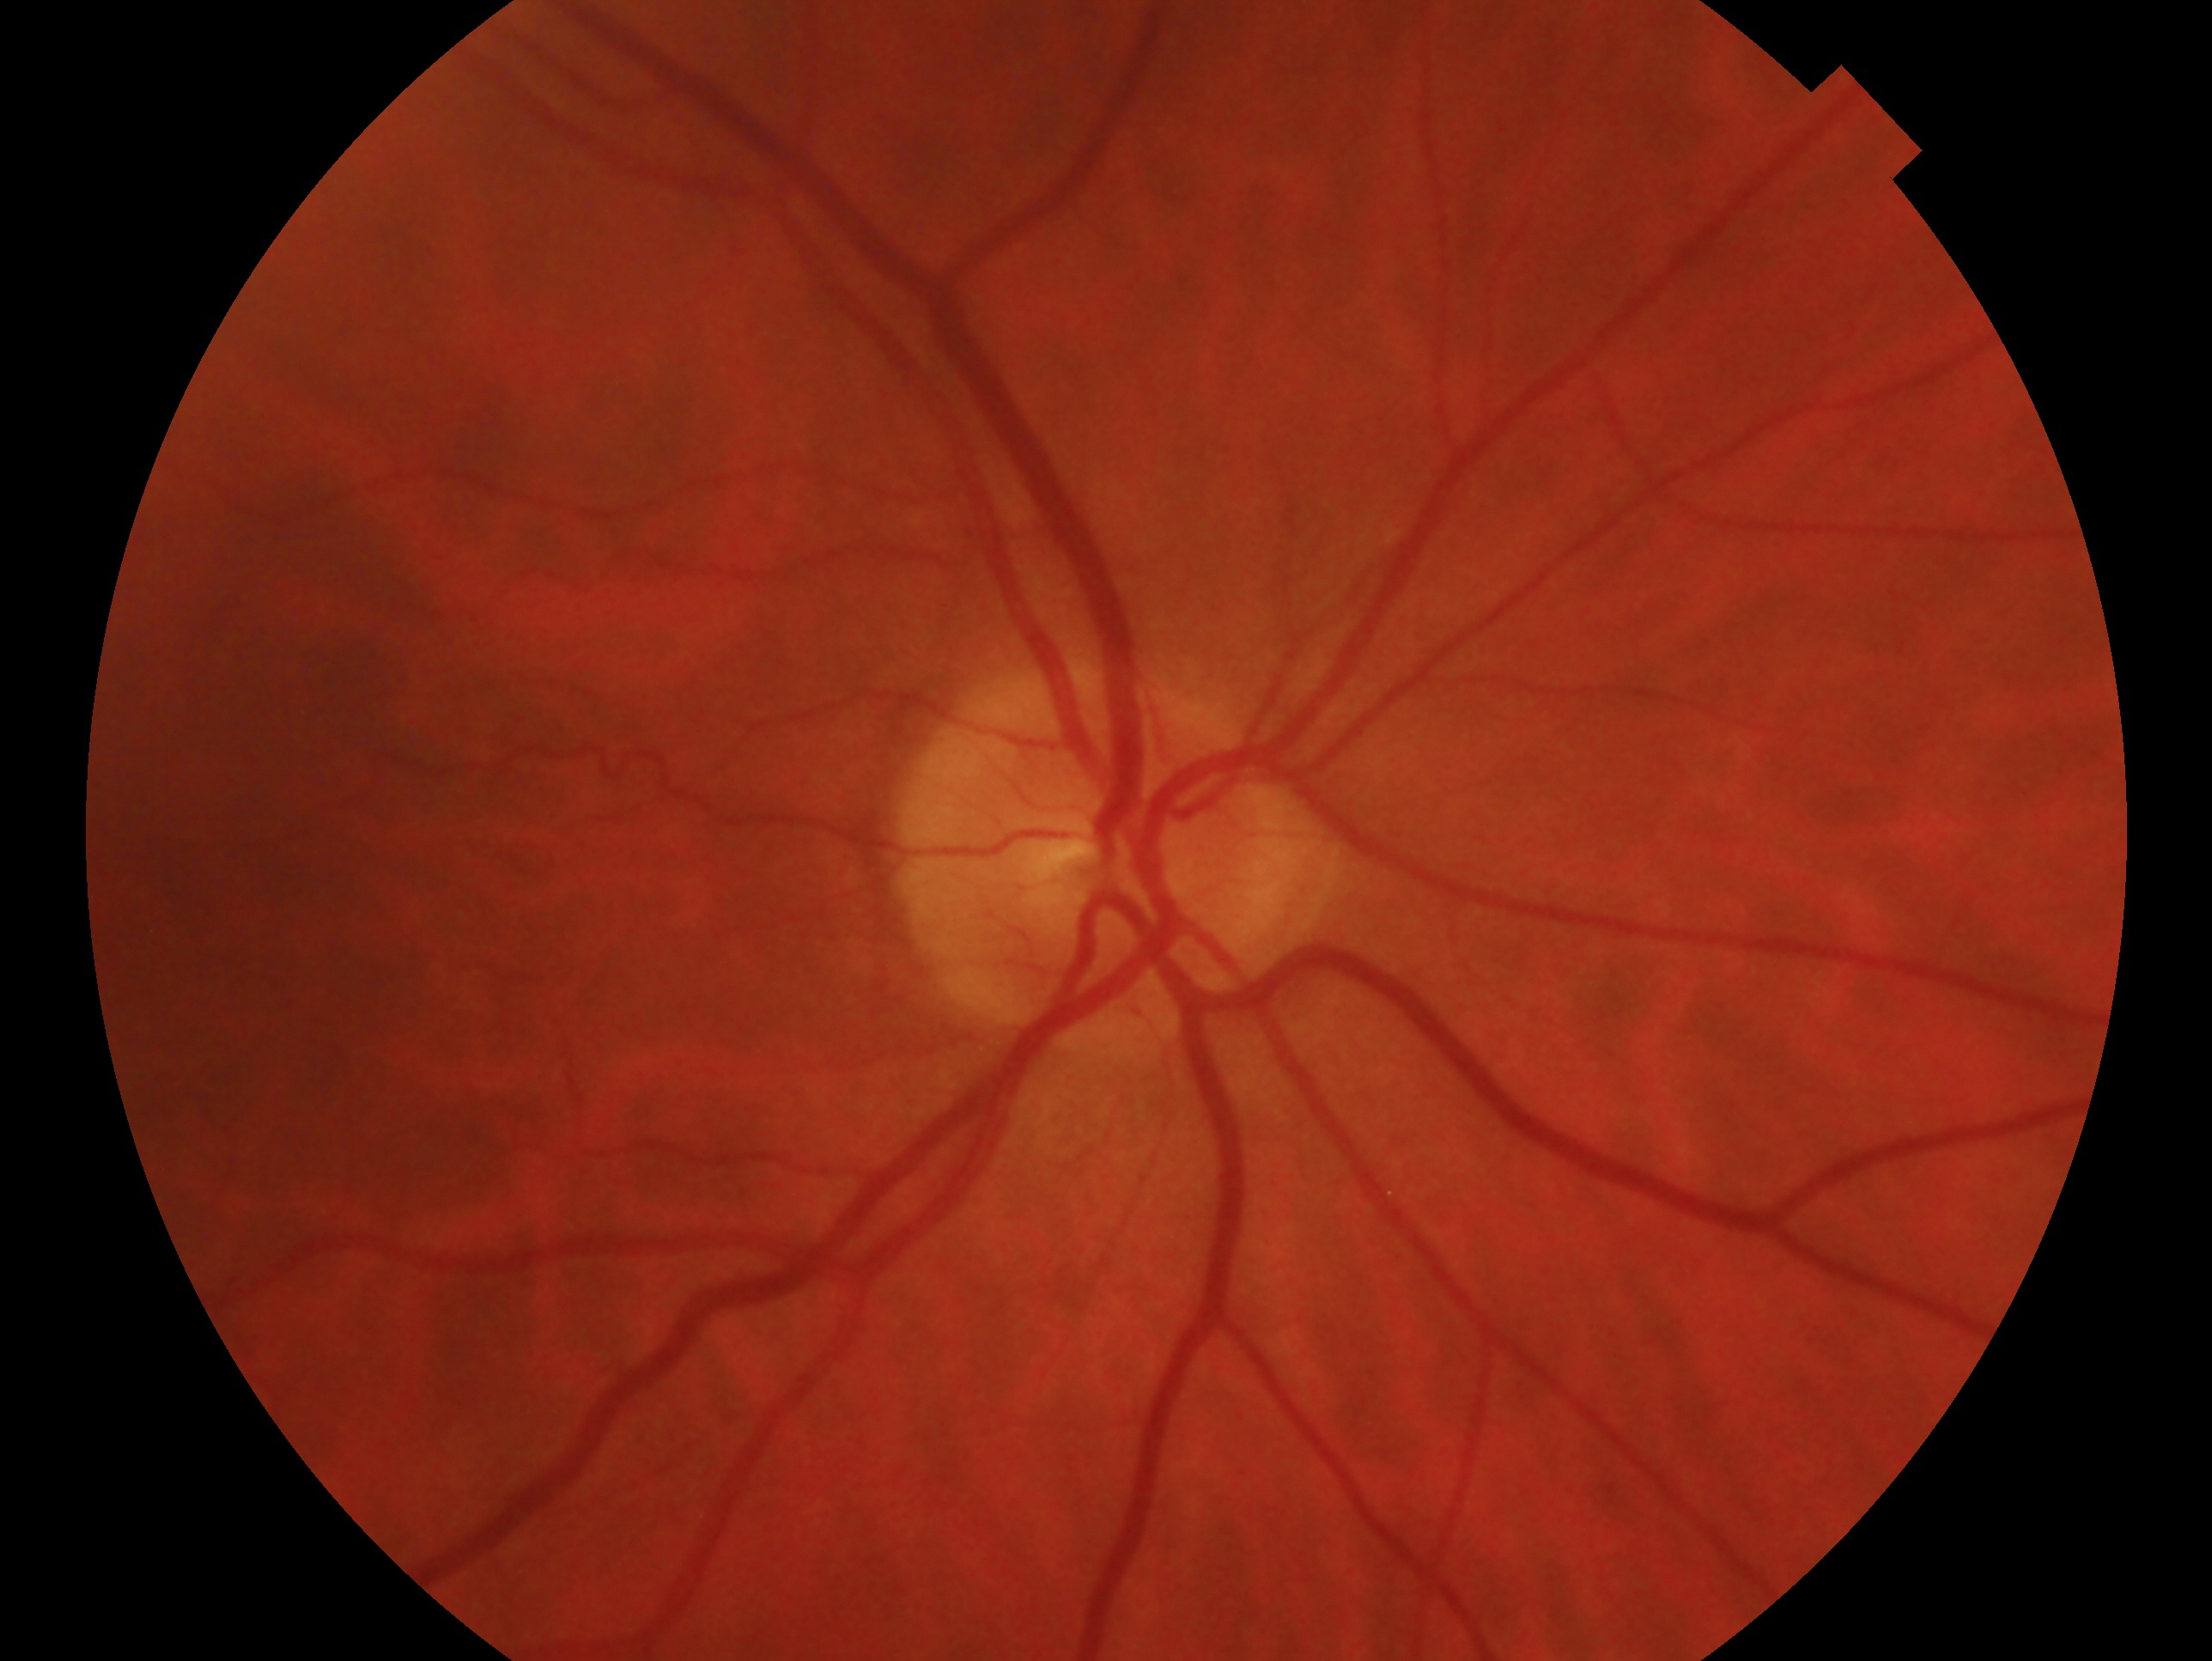 Annotations:
* laterality: right
* clinical classification: no evidence of glaucoma